Color fundus photograph. NIDEK AFC-230 fundus camera.
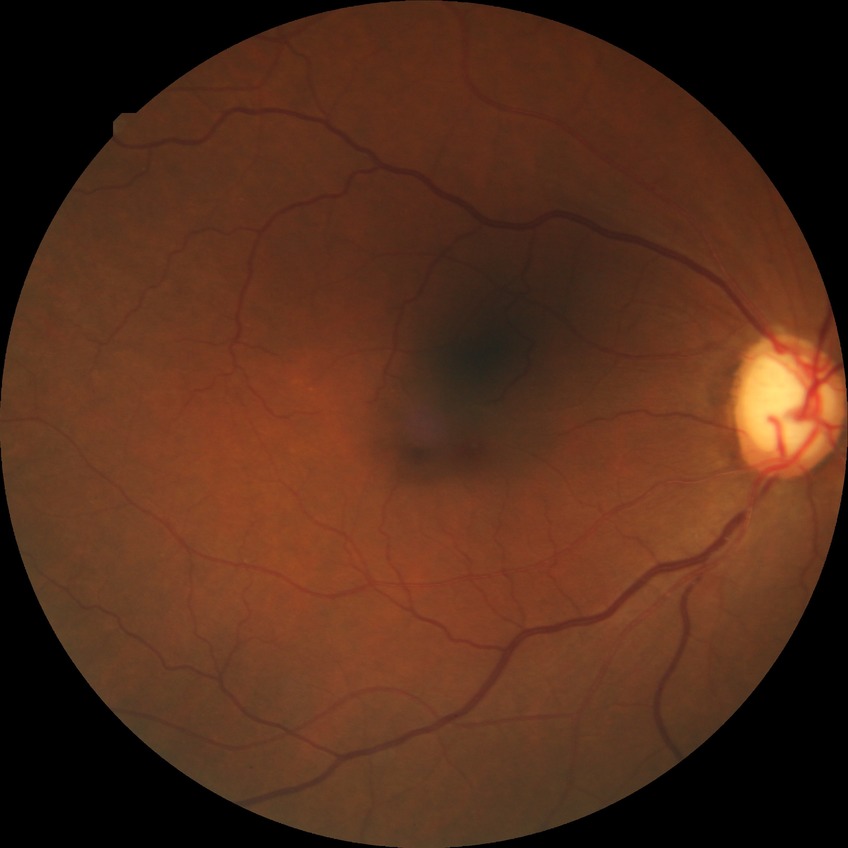

Diabetic retinopathy grade is no diabetic retinopathy.